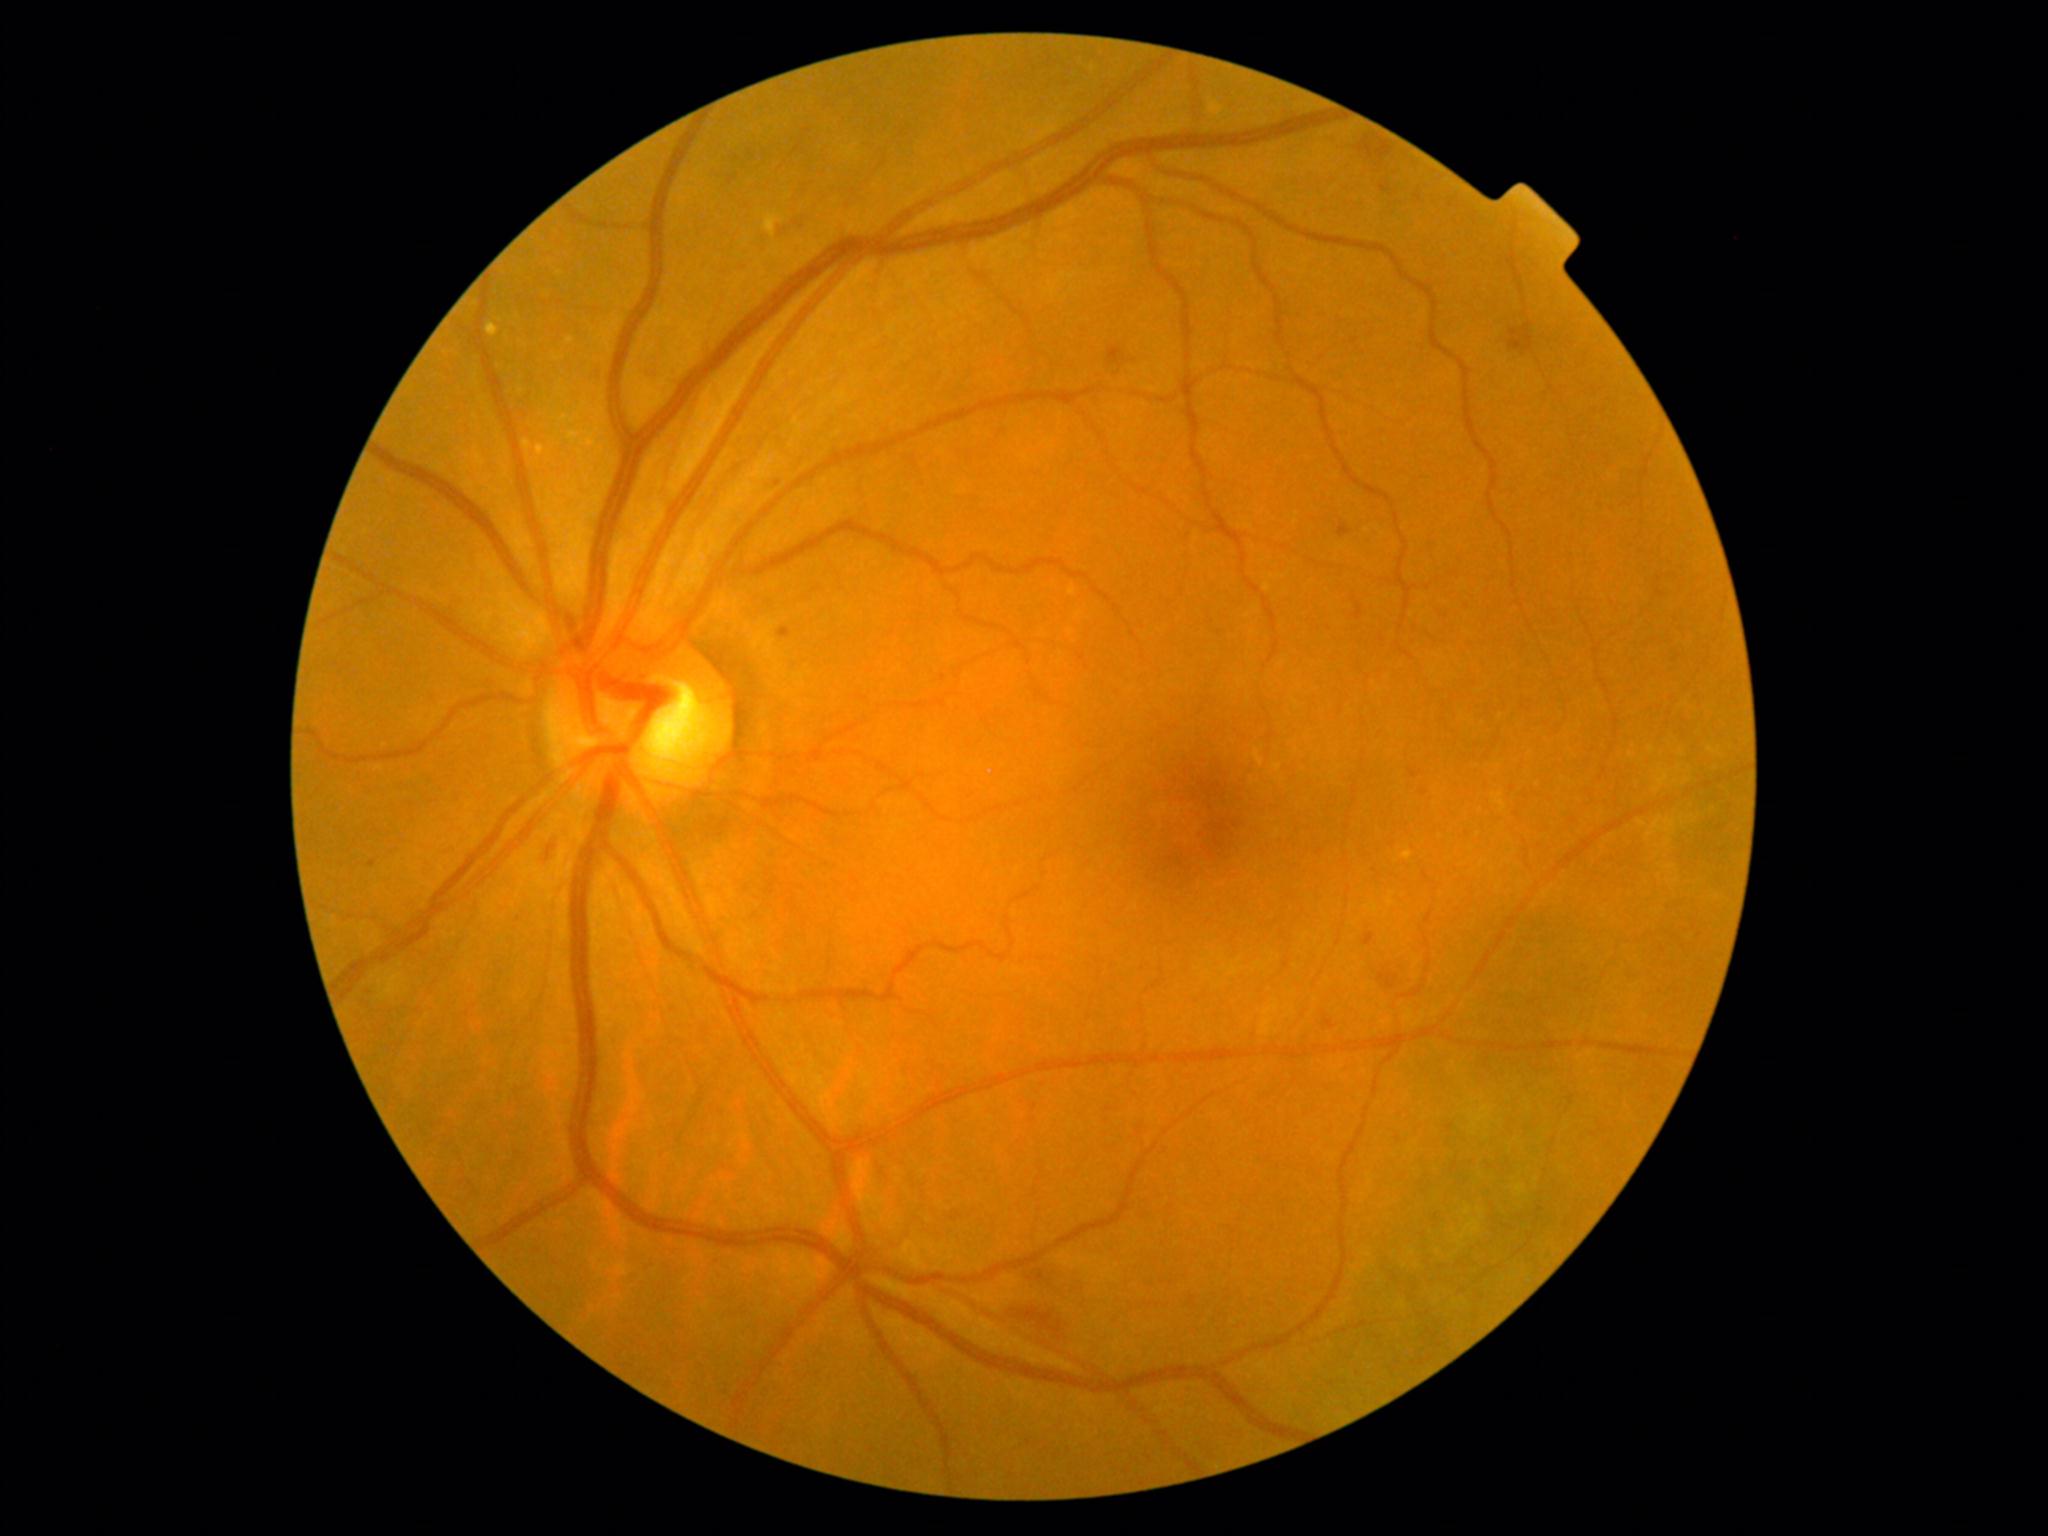

DR stage: grade 2 (moderate NPDR)
SEs: none
HEs: (x1=1023, y1=1307, x2=1066, y2=1340); (x1=1509, y1=323, x2=1533, y2=353); (x1=1358, y1=136, x2=1393, y2=161); (x1=1026, y1=1275, x2=1080, y2=1301); (x1=776, y1=215, x2=802, y2=228); (x1=1377, y1=971, x2=1398, y2=990); (x1=1109, y1=347, x2=1126, y2=366); (x1=1354, y1=604, x2=1364, y2=621); (x1=548, y1=836, x2=565, y2=858)
EXs: (x1=764, y1=214, x2=784, y2=238); (x1=522, y1=442, x2=532, y2=449); (x1=565, y1=340, x2=575, y2=346); (x1=536, y1=448, x2=546, y2=455); (x1=582, y1=440, x2=597, y2=449); (x1=569, y1=435, x2=579, y2=442); (x1=485, y1=321, x2=500, y2=337)
MAs: (x1=1338, y1=524, x2=1351, y2=538); (x1=597, y1=366, x2=601, y2=374); (x1=1363, y1=934, x2=1376, y2=947); (x1=1325, y1=1019, x2=1335, y2=1030); (x1=648, y1=373, x2=655, y2=383); (x1=1380, y1=185, x2=1391, y2=194); (x1=1409, y1=769, x2=1423, y2=779); (x1=779, y1=628, x2=792, y2=638)
Small MAs approximately at 373:864; 778:485; 1424:794; 1418:198